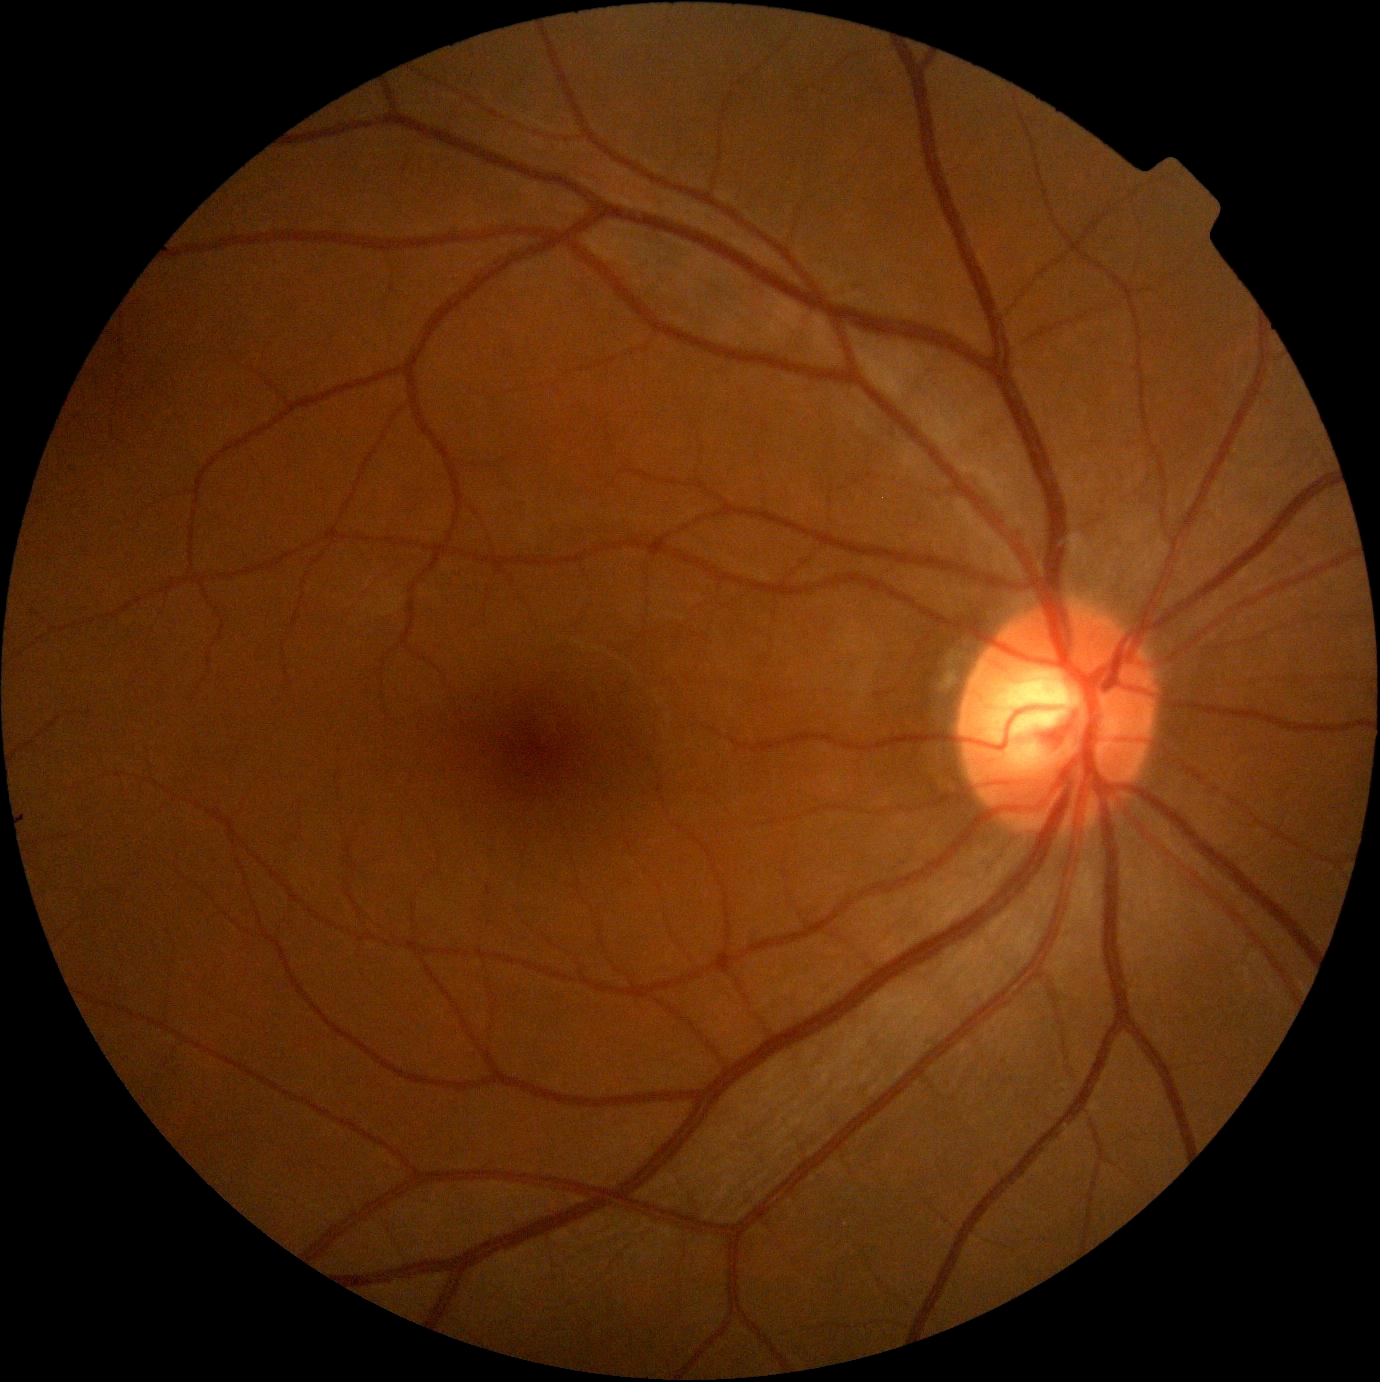 No diabetic retinal disease findings. Diabetic retinopathy (DR) is no apparent retinopathy (grade 0).